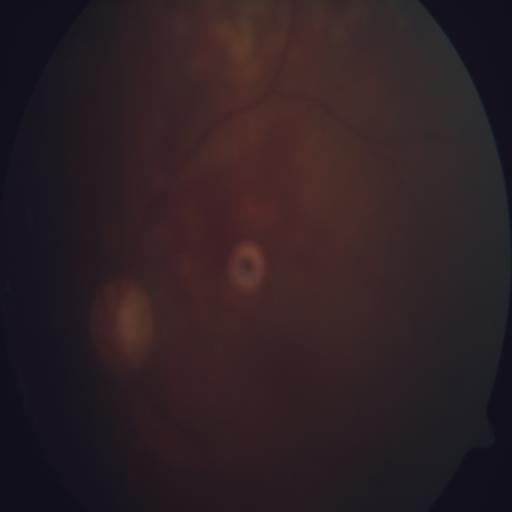

Diagnoses: retinitis.